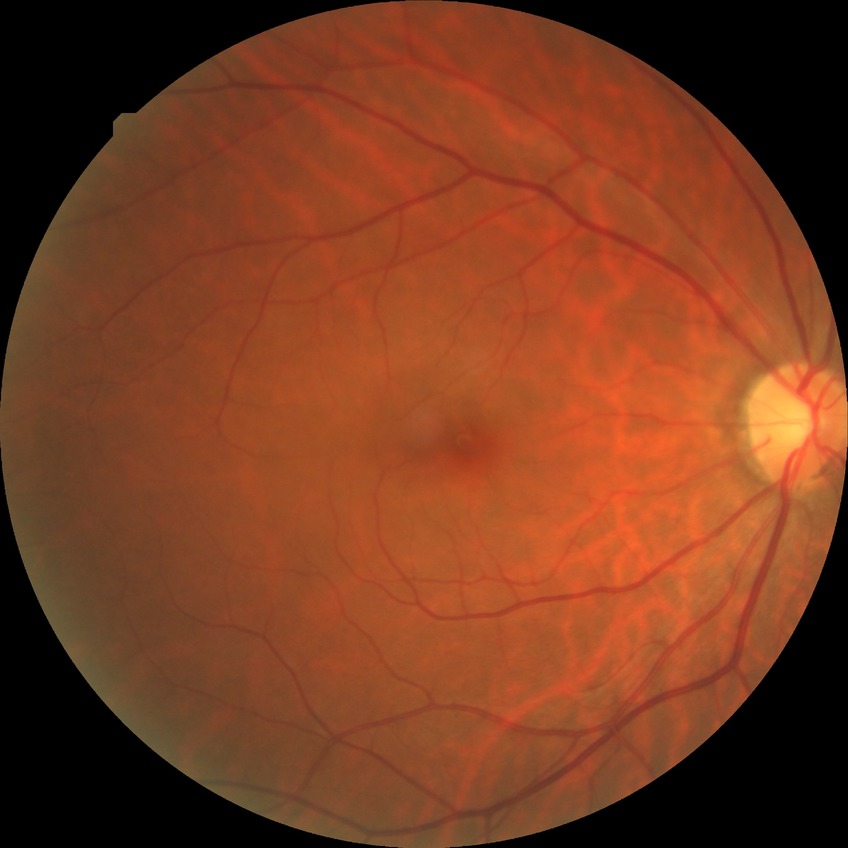
Diabetic retinopathy (DR): NDR (no diabetic retinopathy).